Captured with the Clarity RetCam 3 (130° field of view). Pediatric retinal photograph (wide-field):
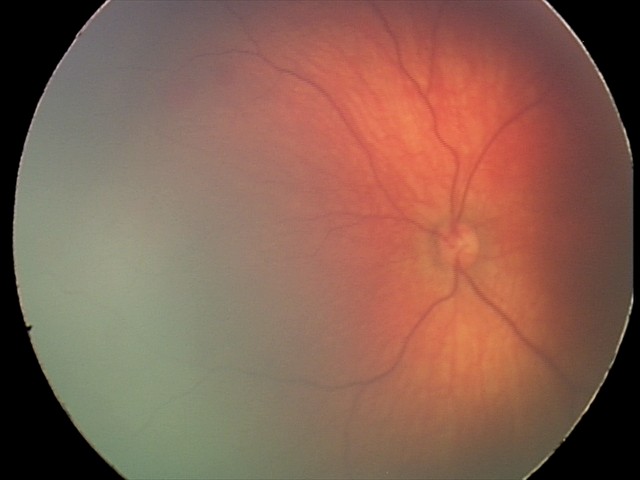
Diagnosis from this screening exam: retinal hemorrhages.